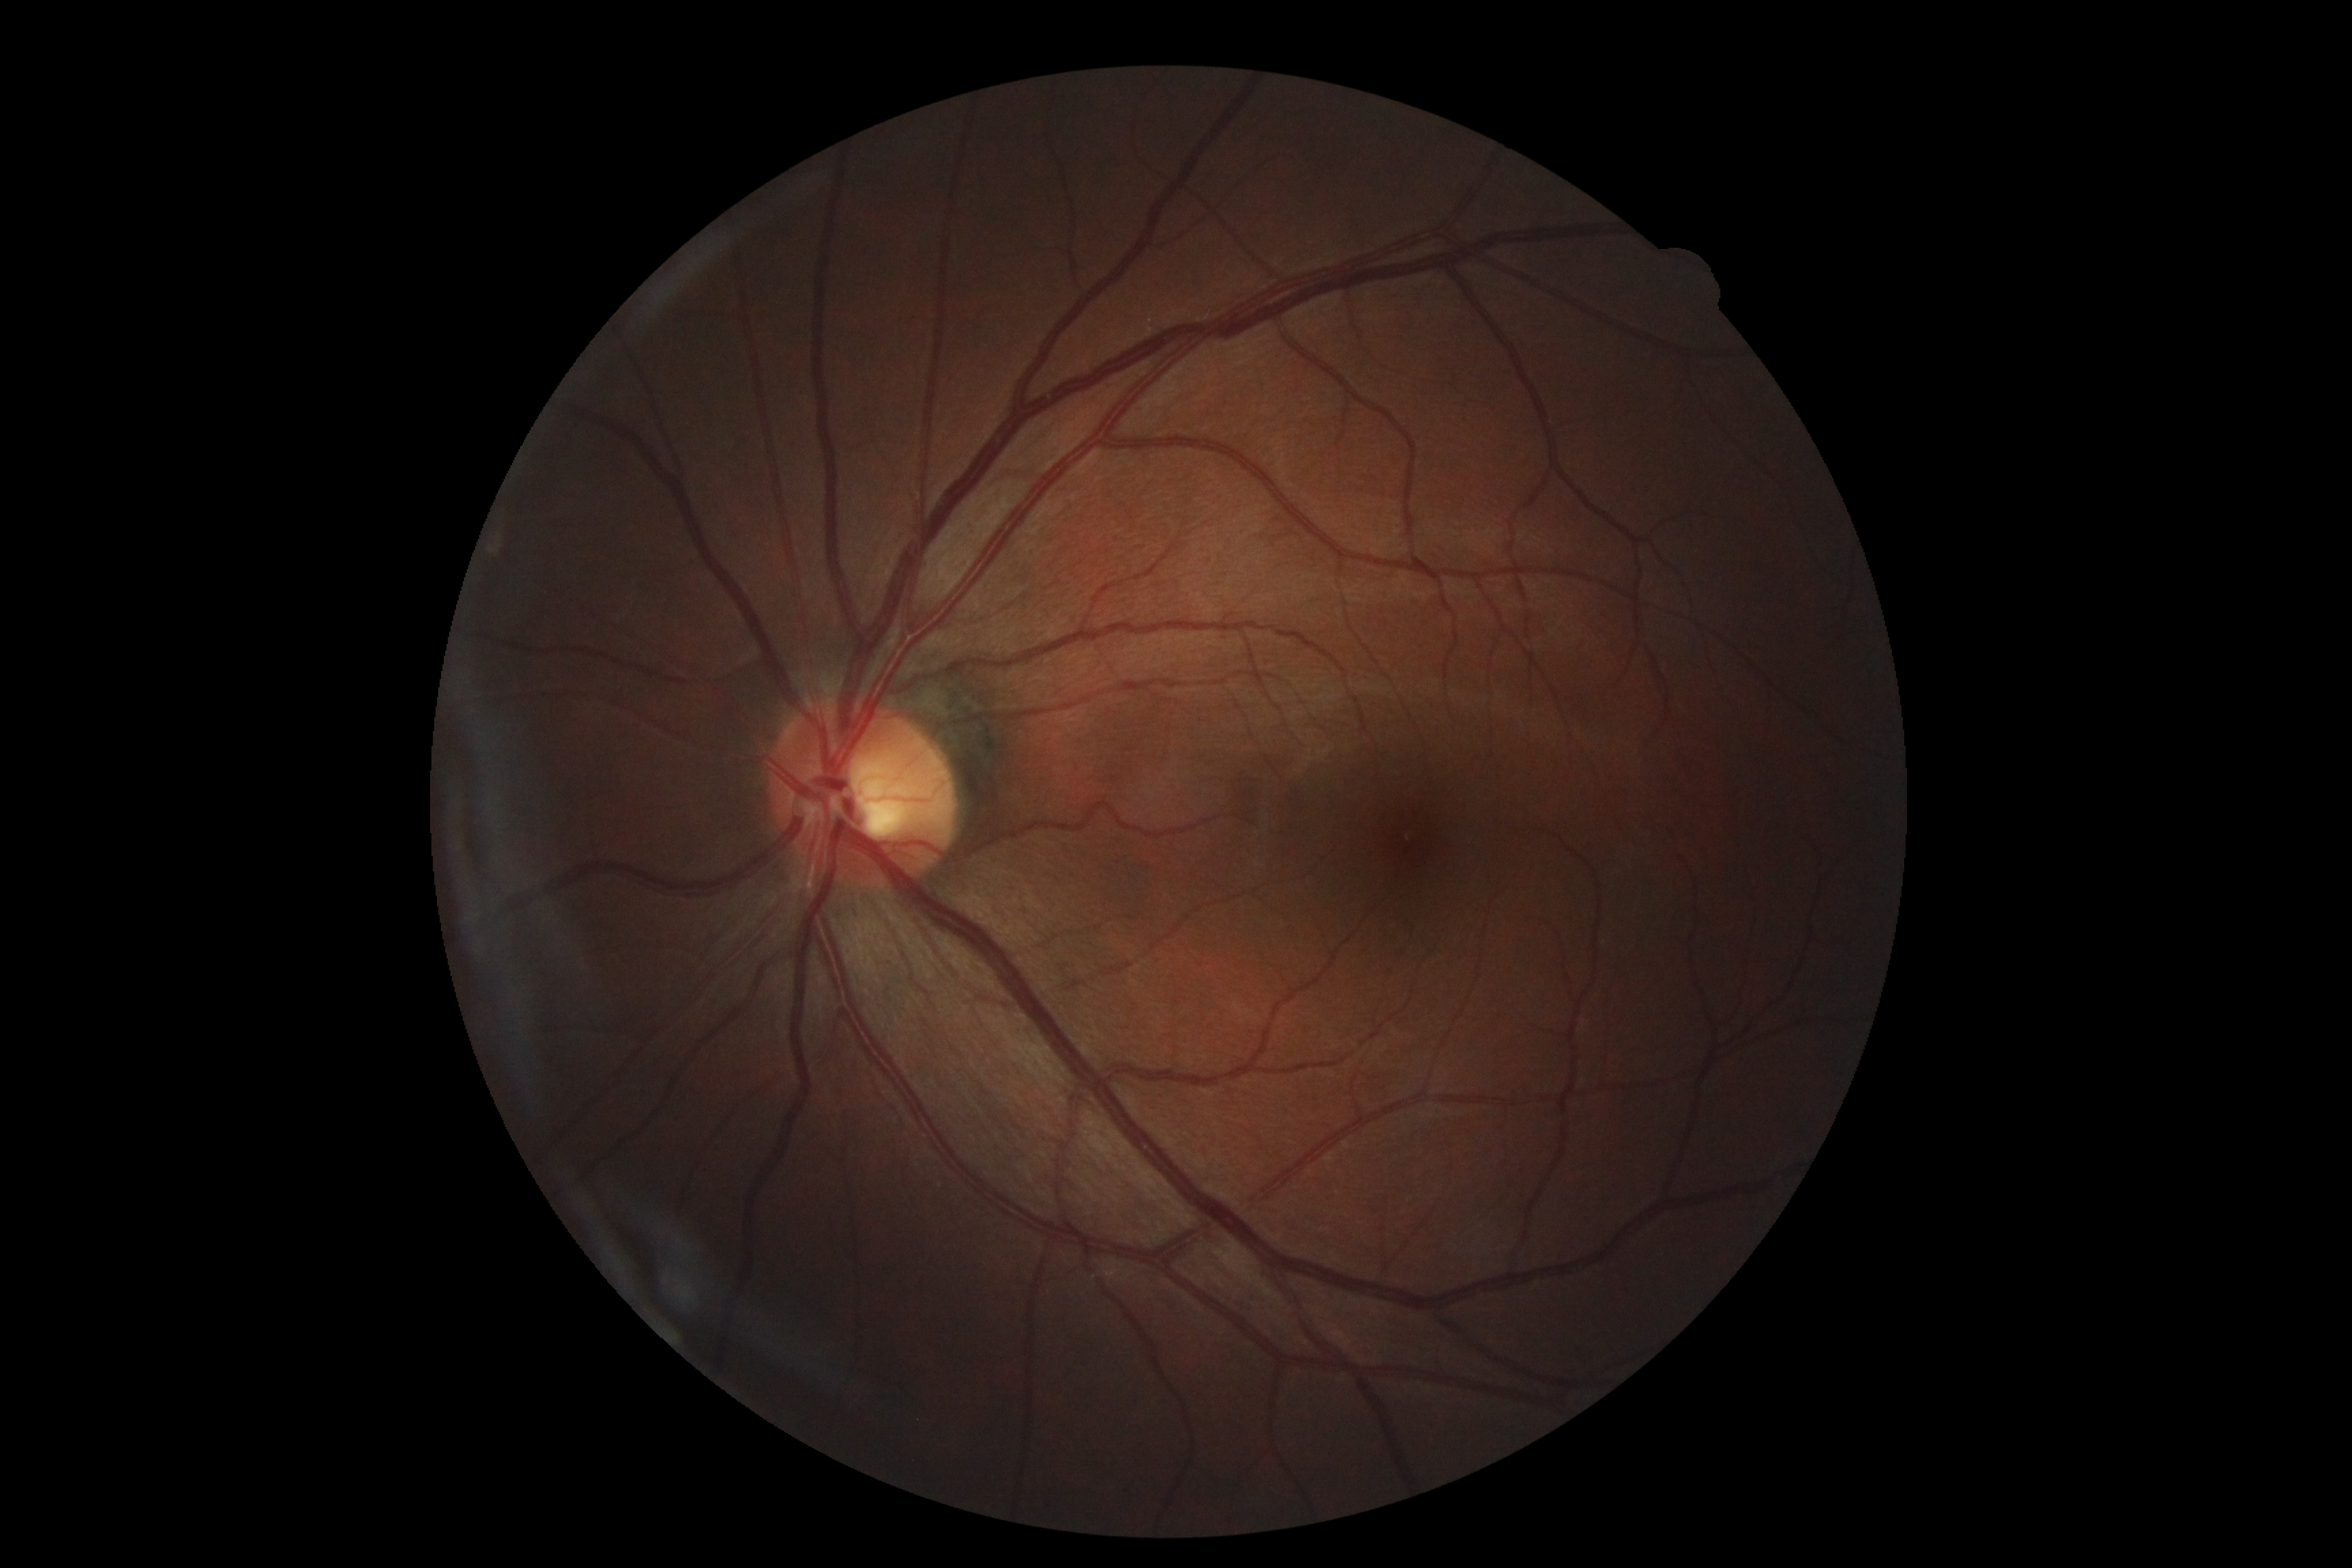
retinopathy grade: 0/4; DR impression: negative for DR.